RetCam wide-field infant fundus image; 640x480:
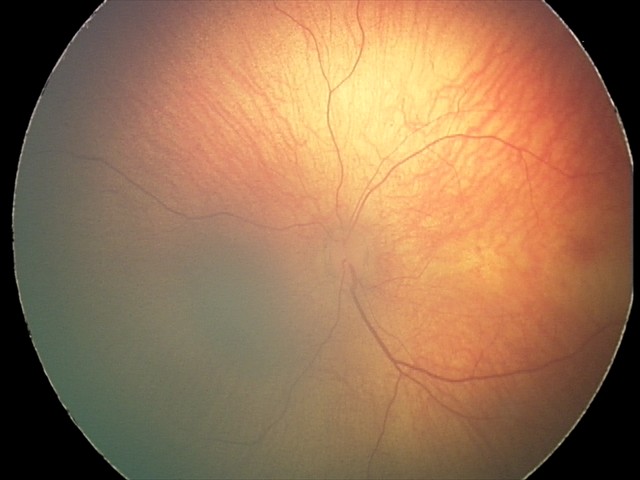 Examination with physiological retinal findings.